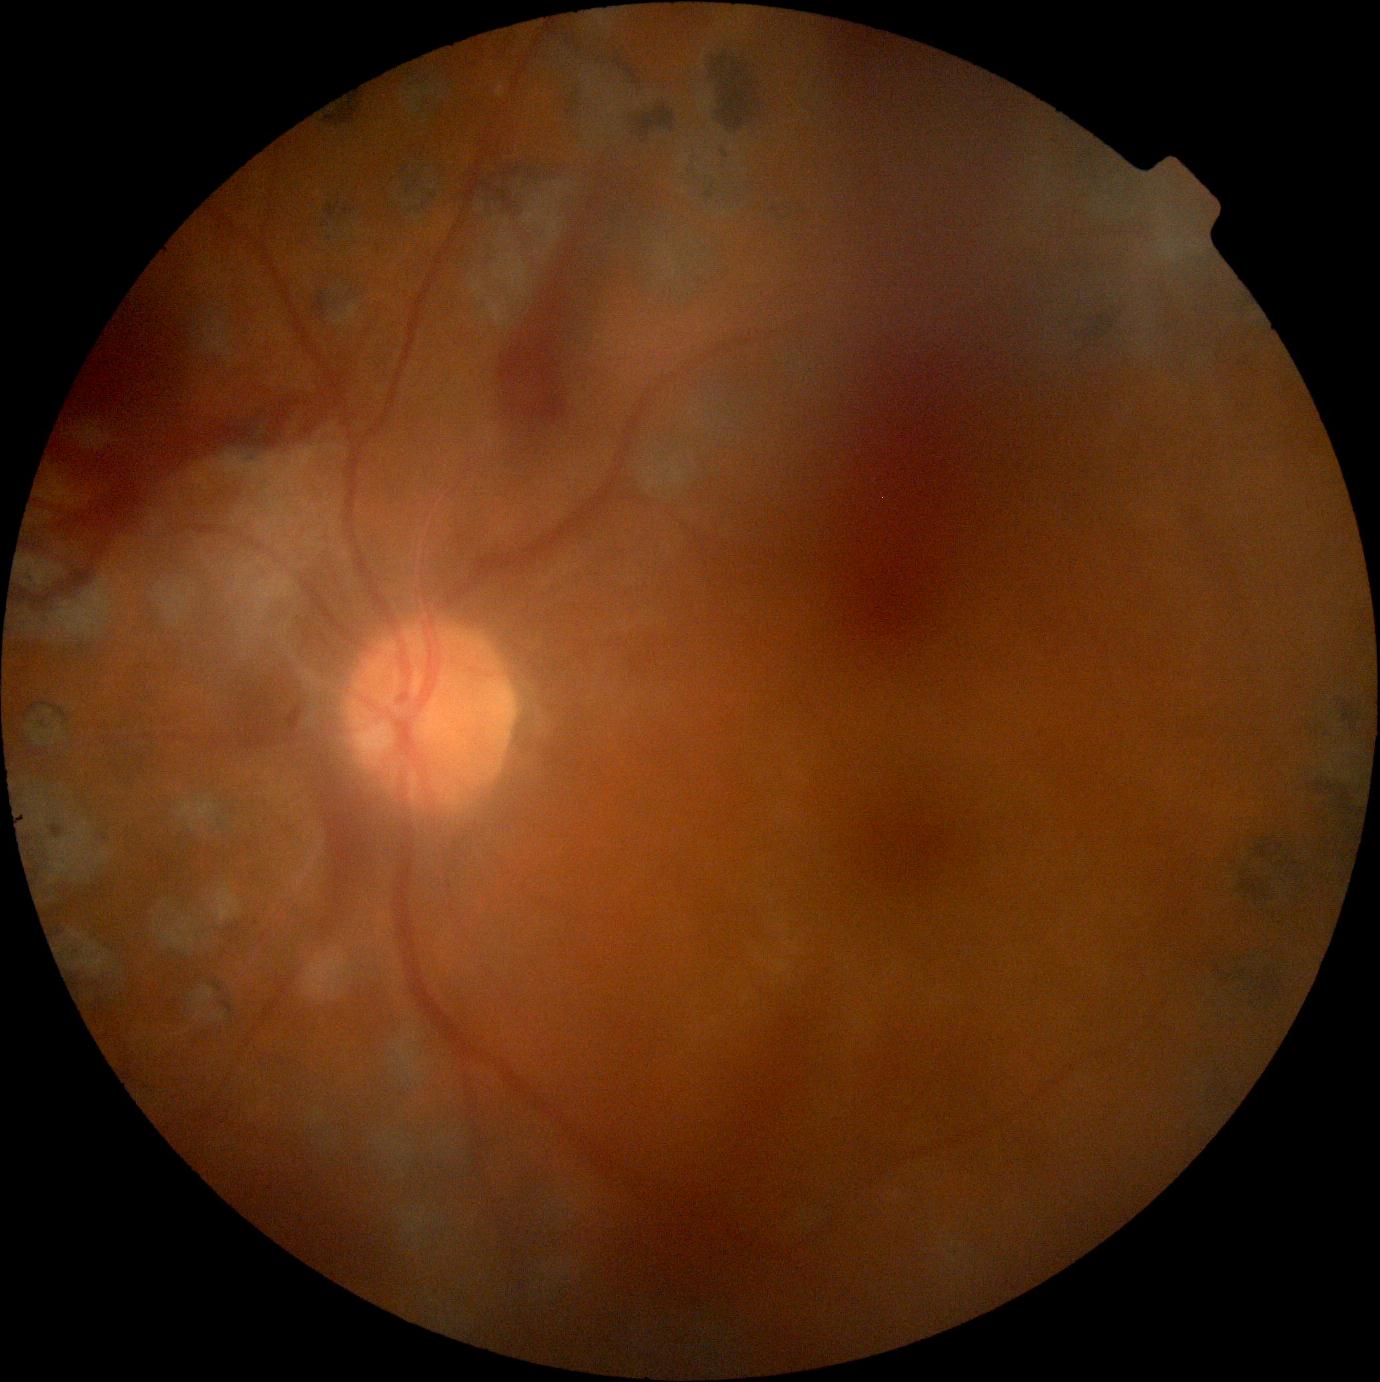
dr_category: proliferative diabetic retinopathy
dr_grade: grade 4 (PDR)